640 by 480 pixels. Infant wide-field retinal image.
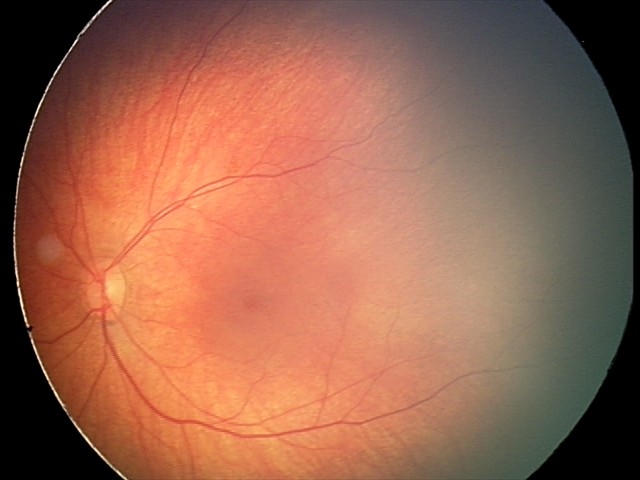 Impression: retinal hemorrhages.